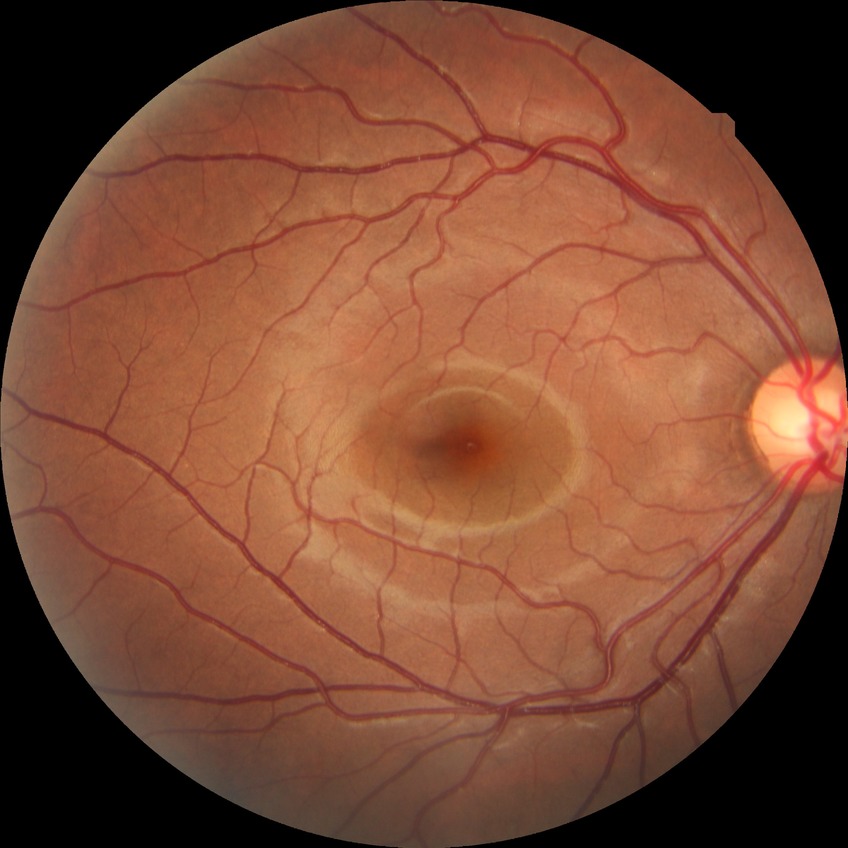 Diabetic retinopathy grade: no diabetic retinopathy.